Pediatric wide-field fundus photograph; acquired on the Phoenix ICON
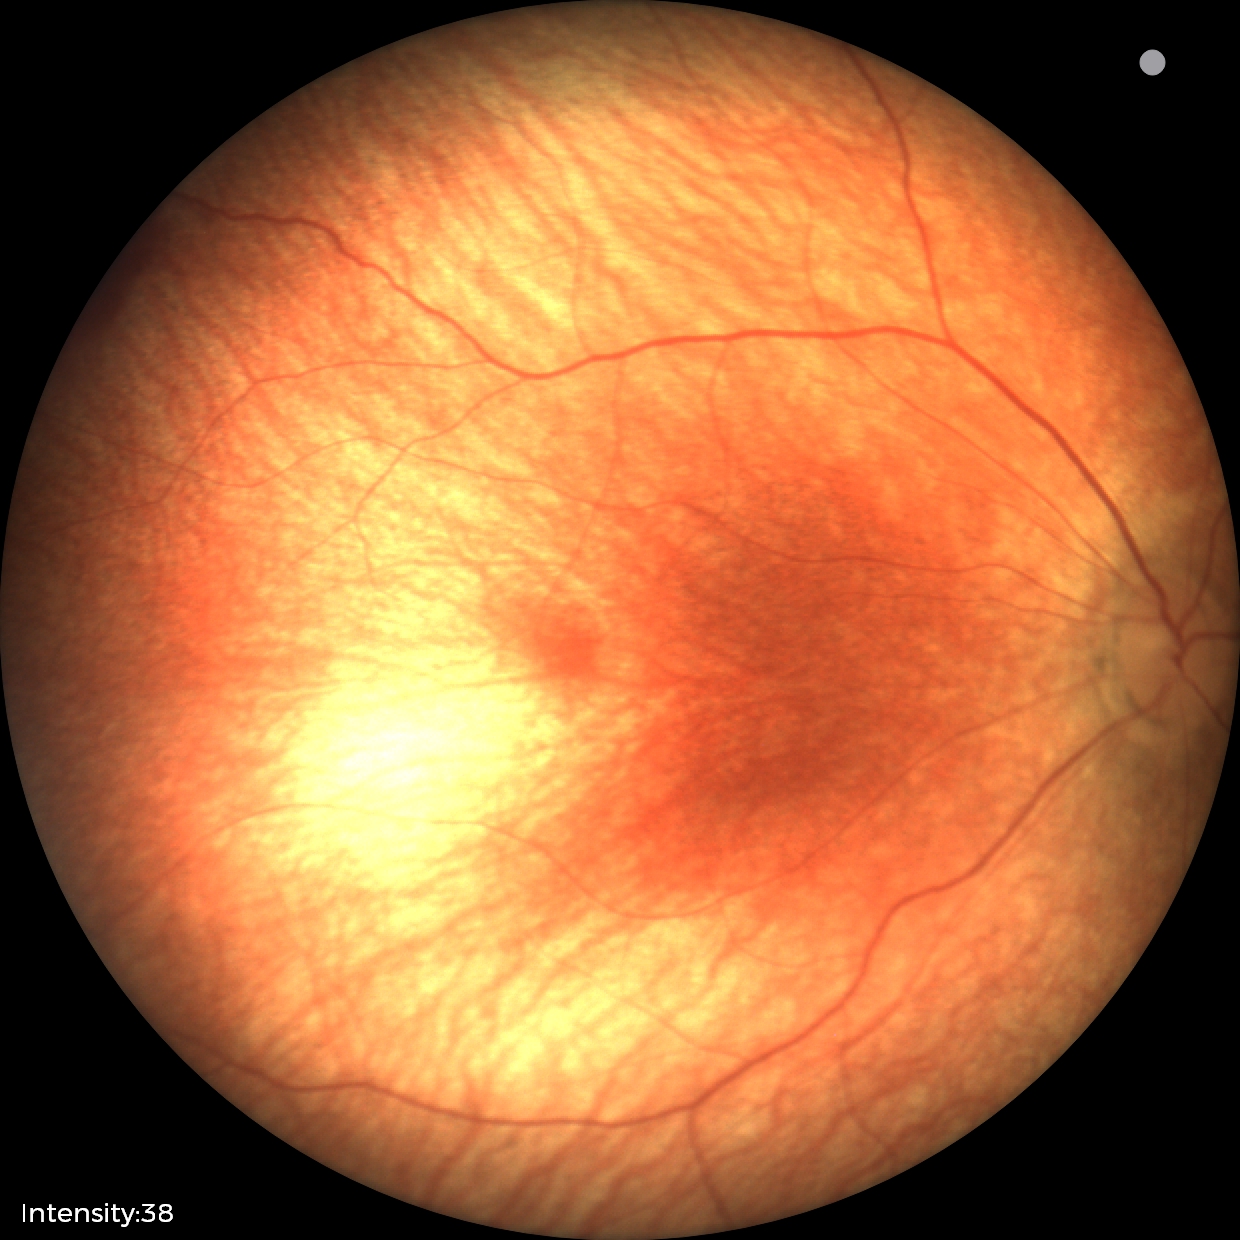 From an examination with diagnosis of retinal hemorrhages.